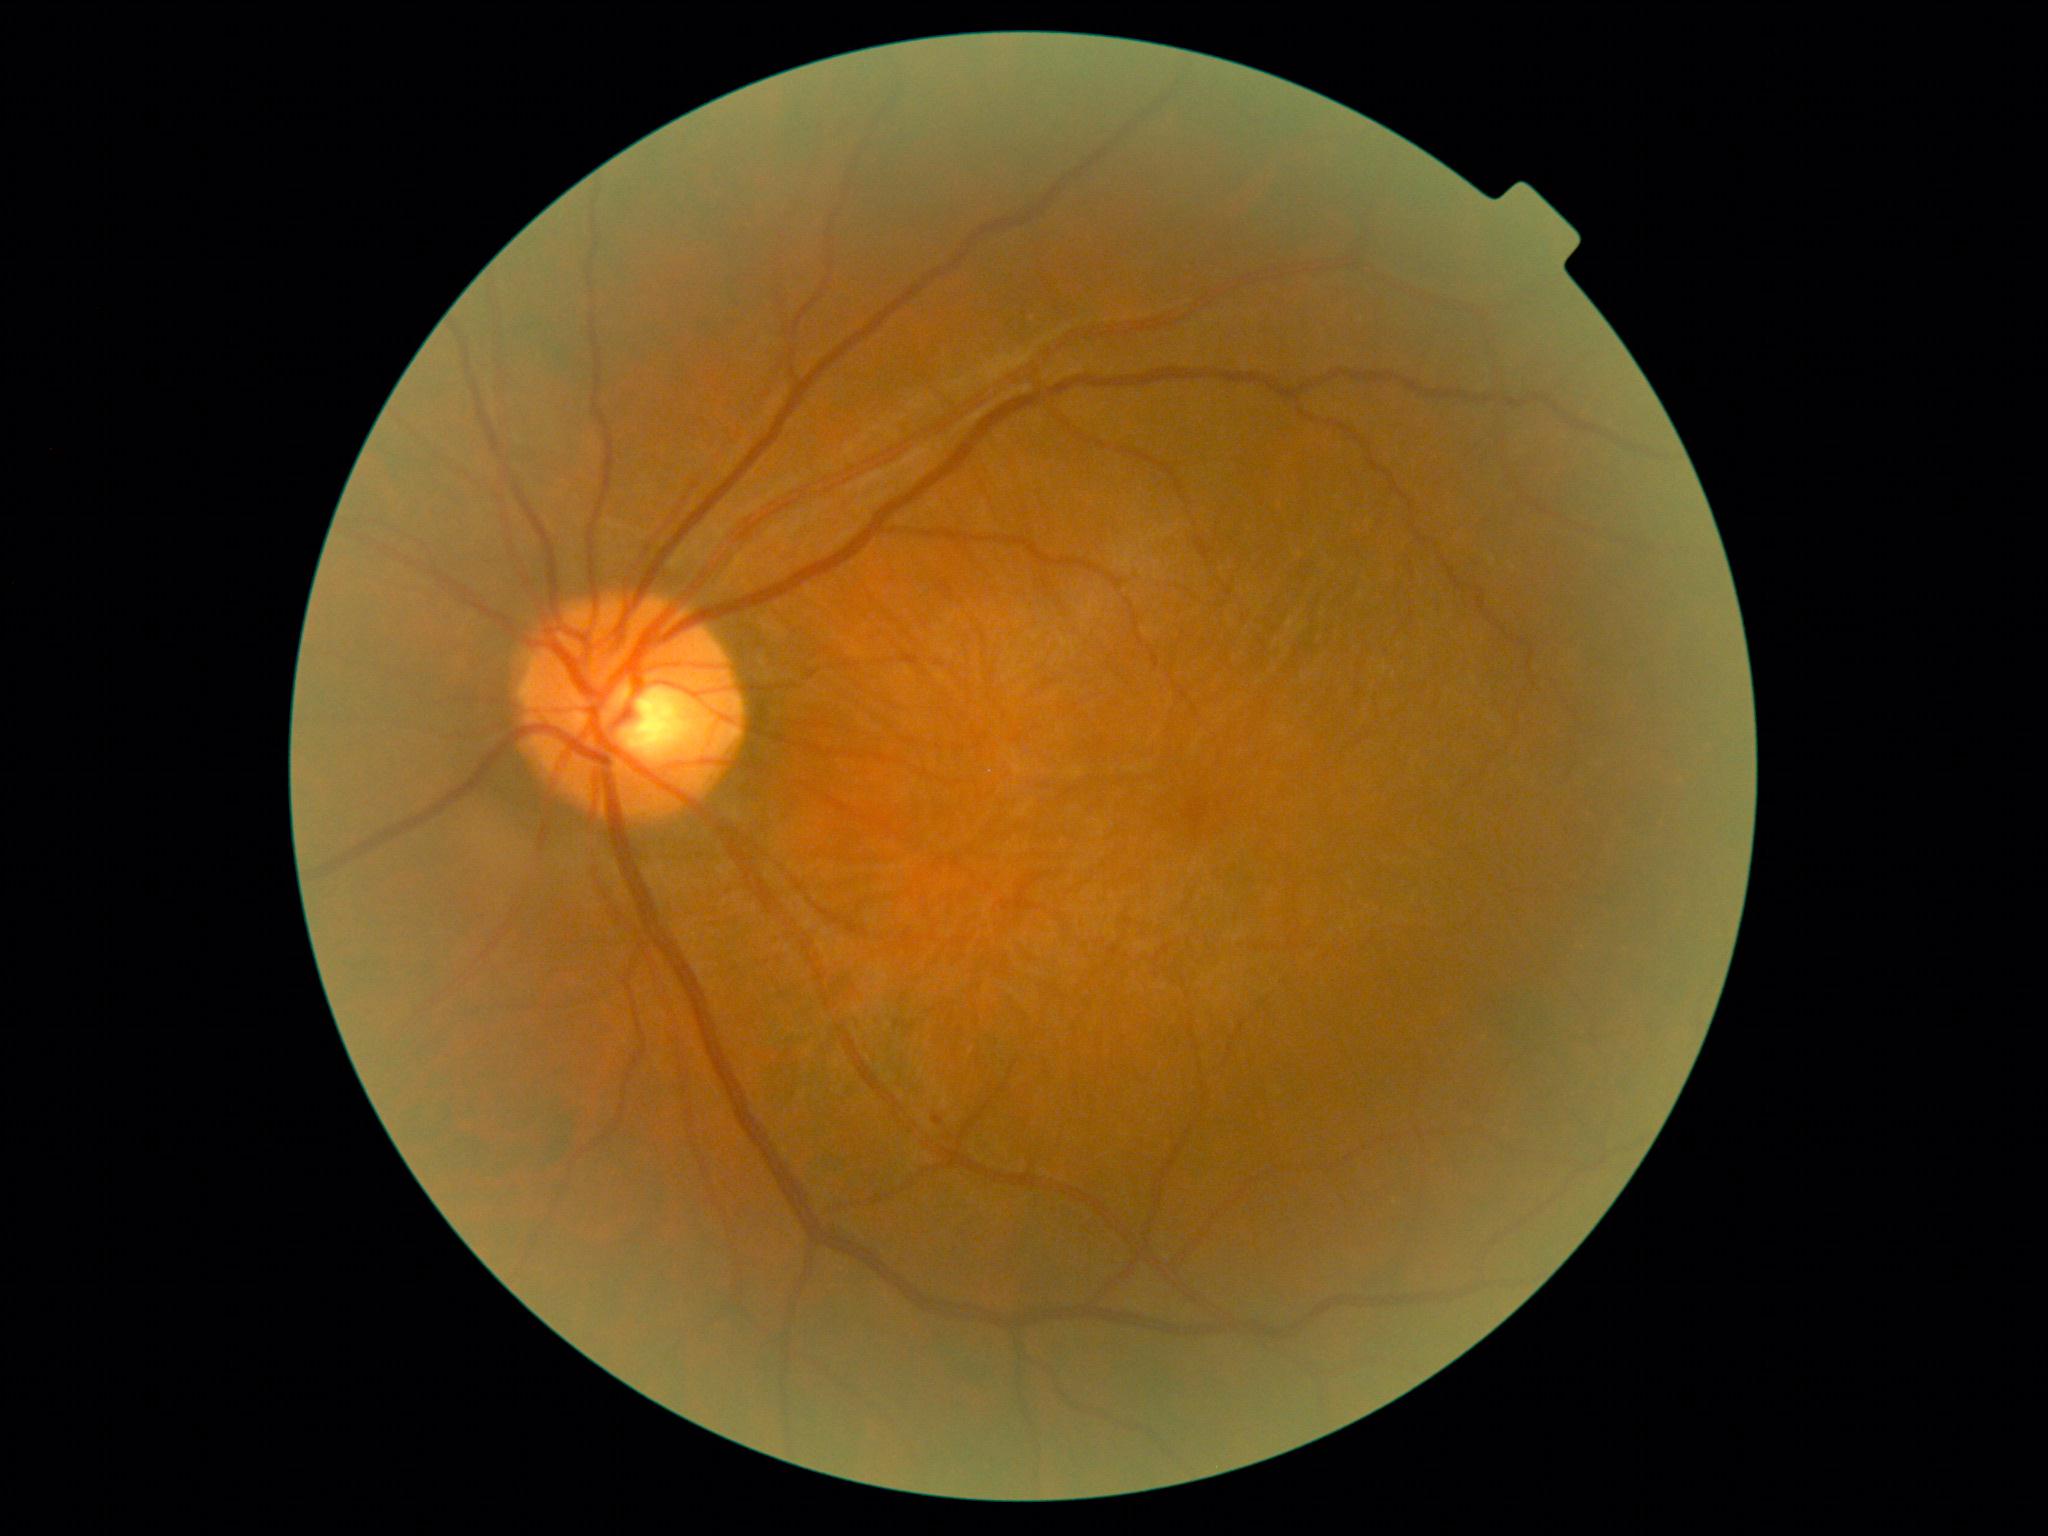

DR is grade 1 (mild NPDR) — presence of microaneurysms only.